Nonmydriatic fundus photograph; color fundus image.
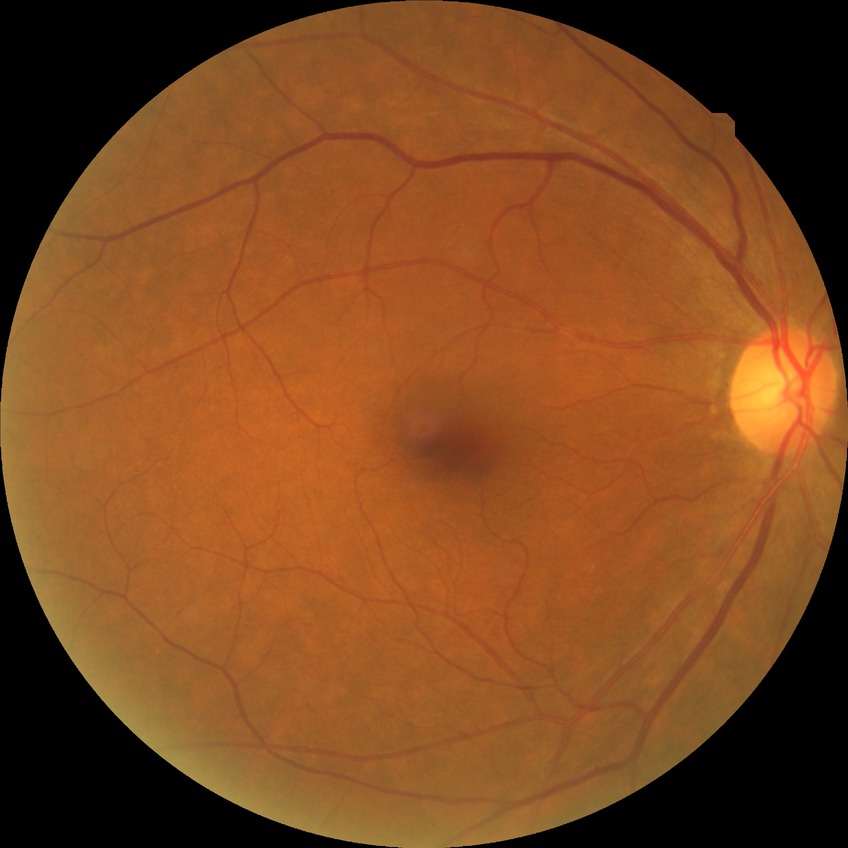 Davis grade@NDR.